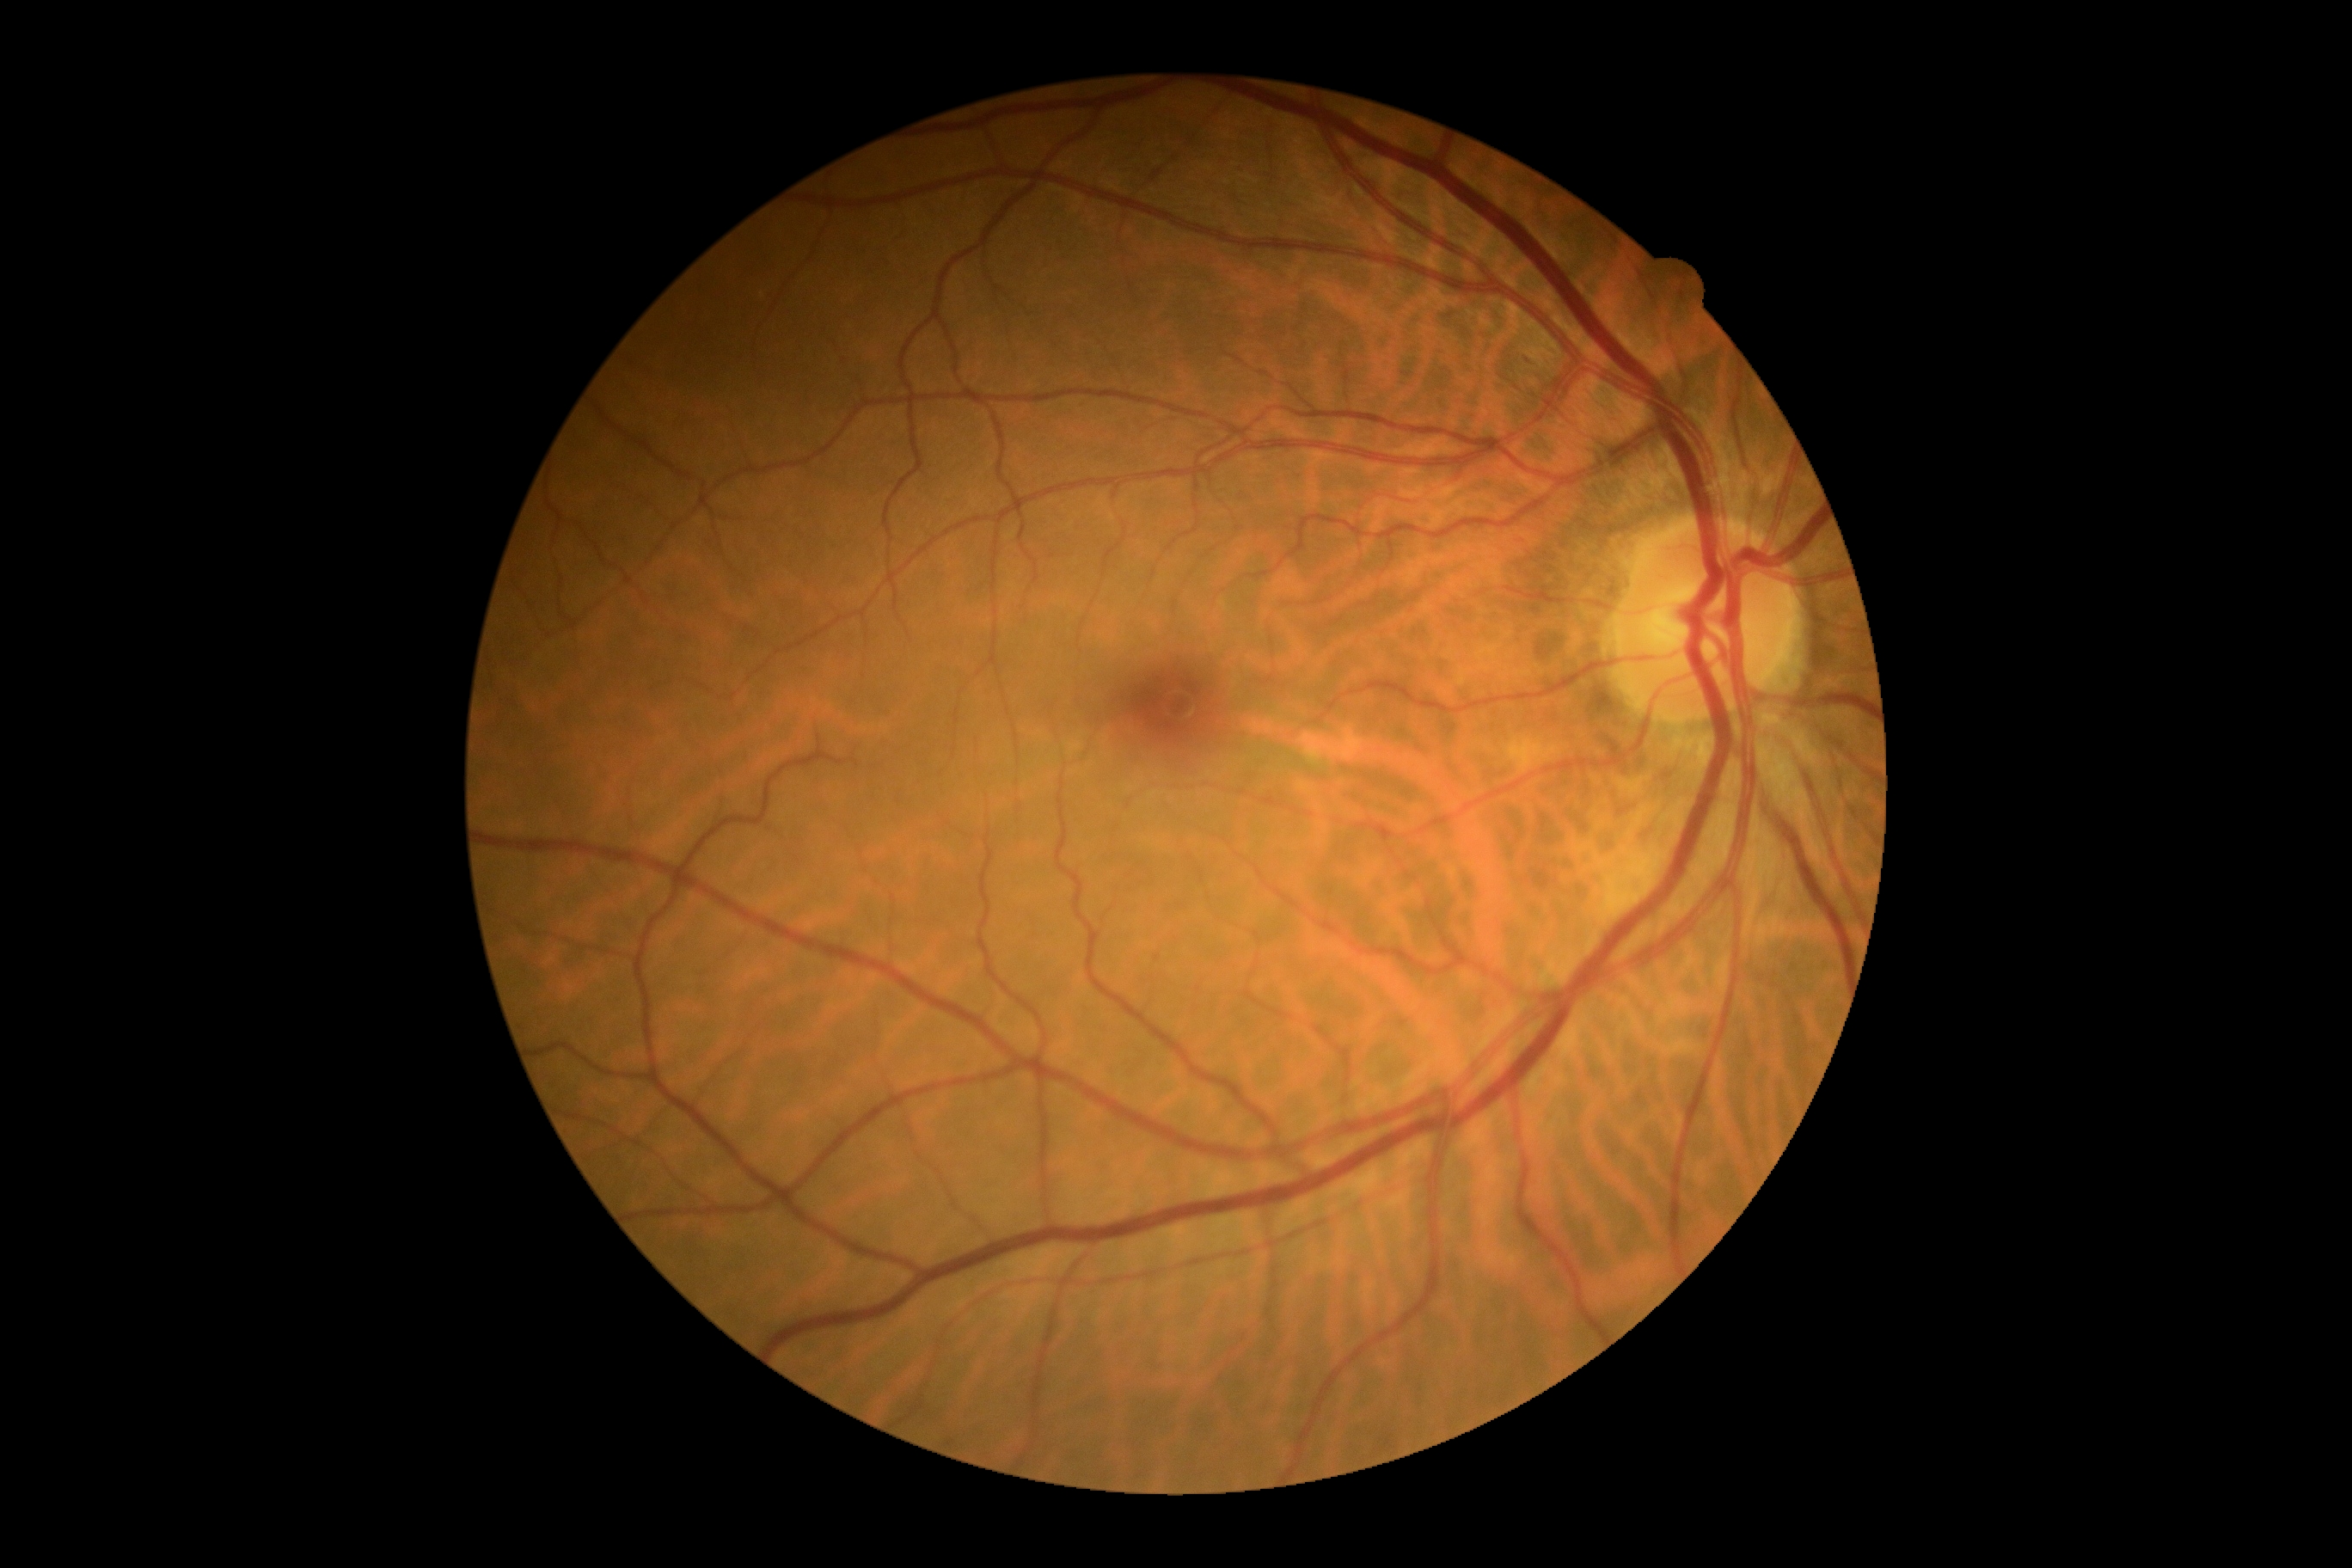
DR grade: 0.